FOV: 45 degrees; CFP:
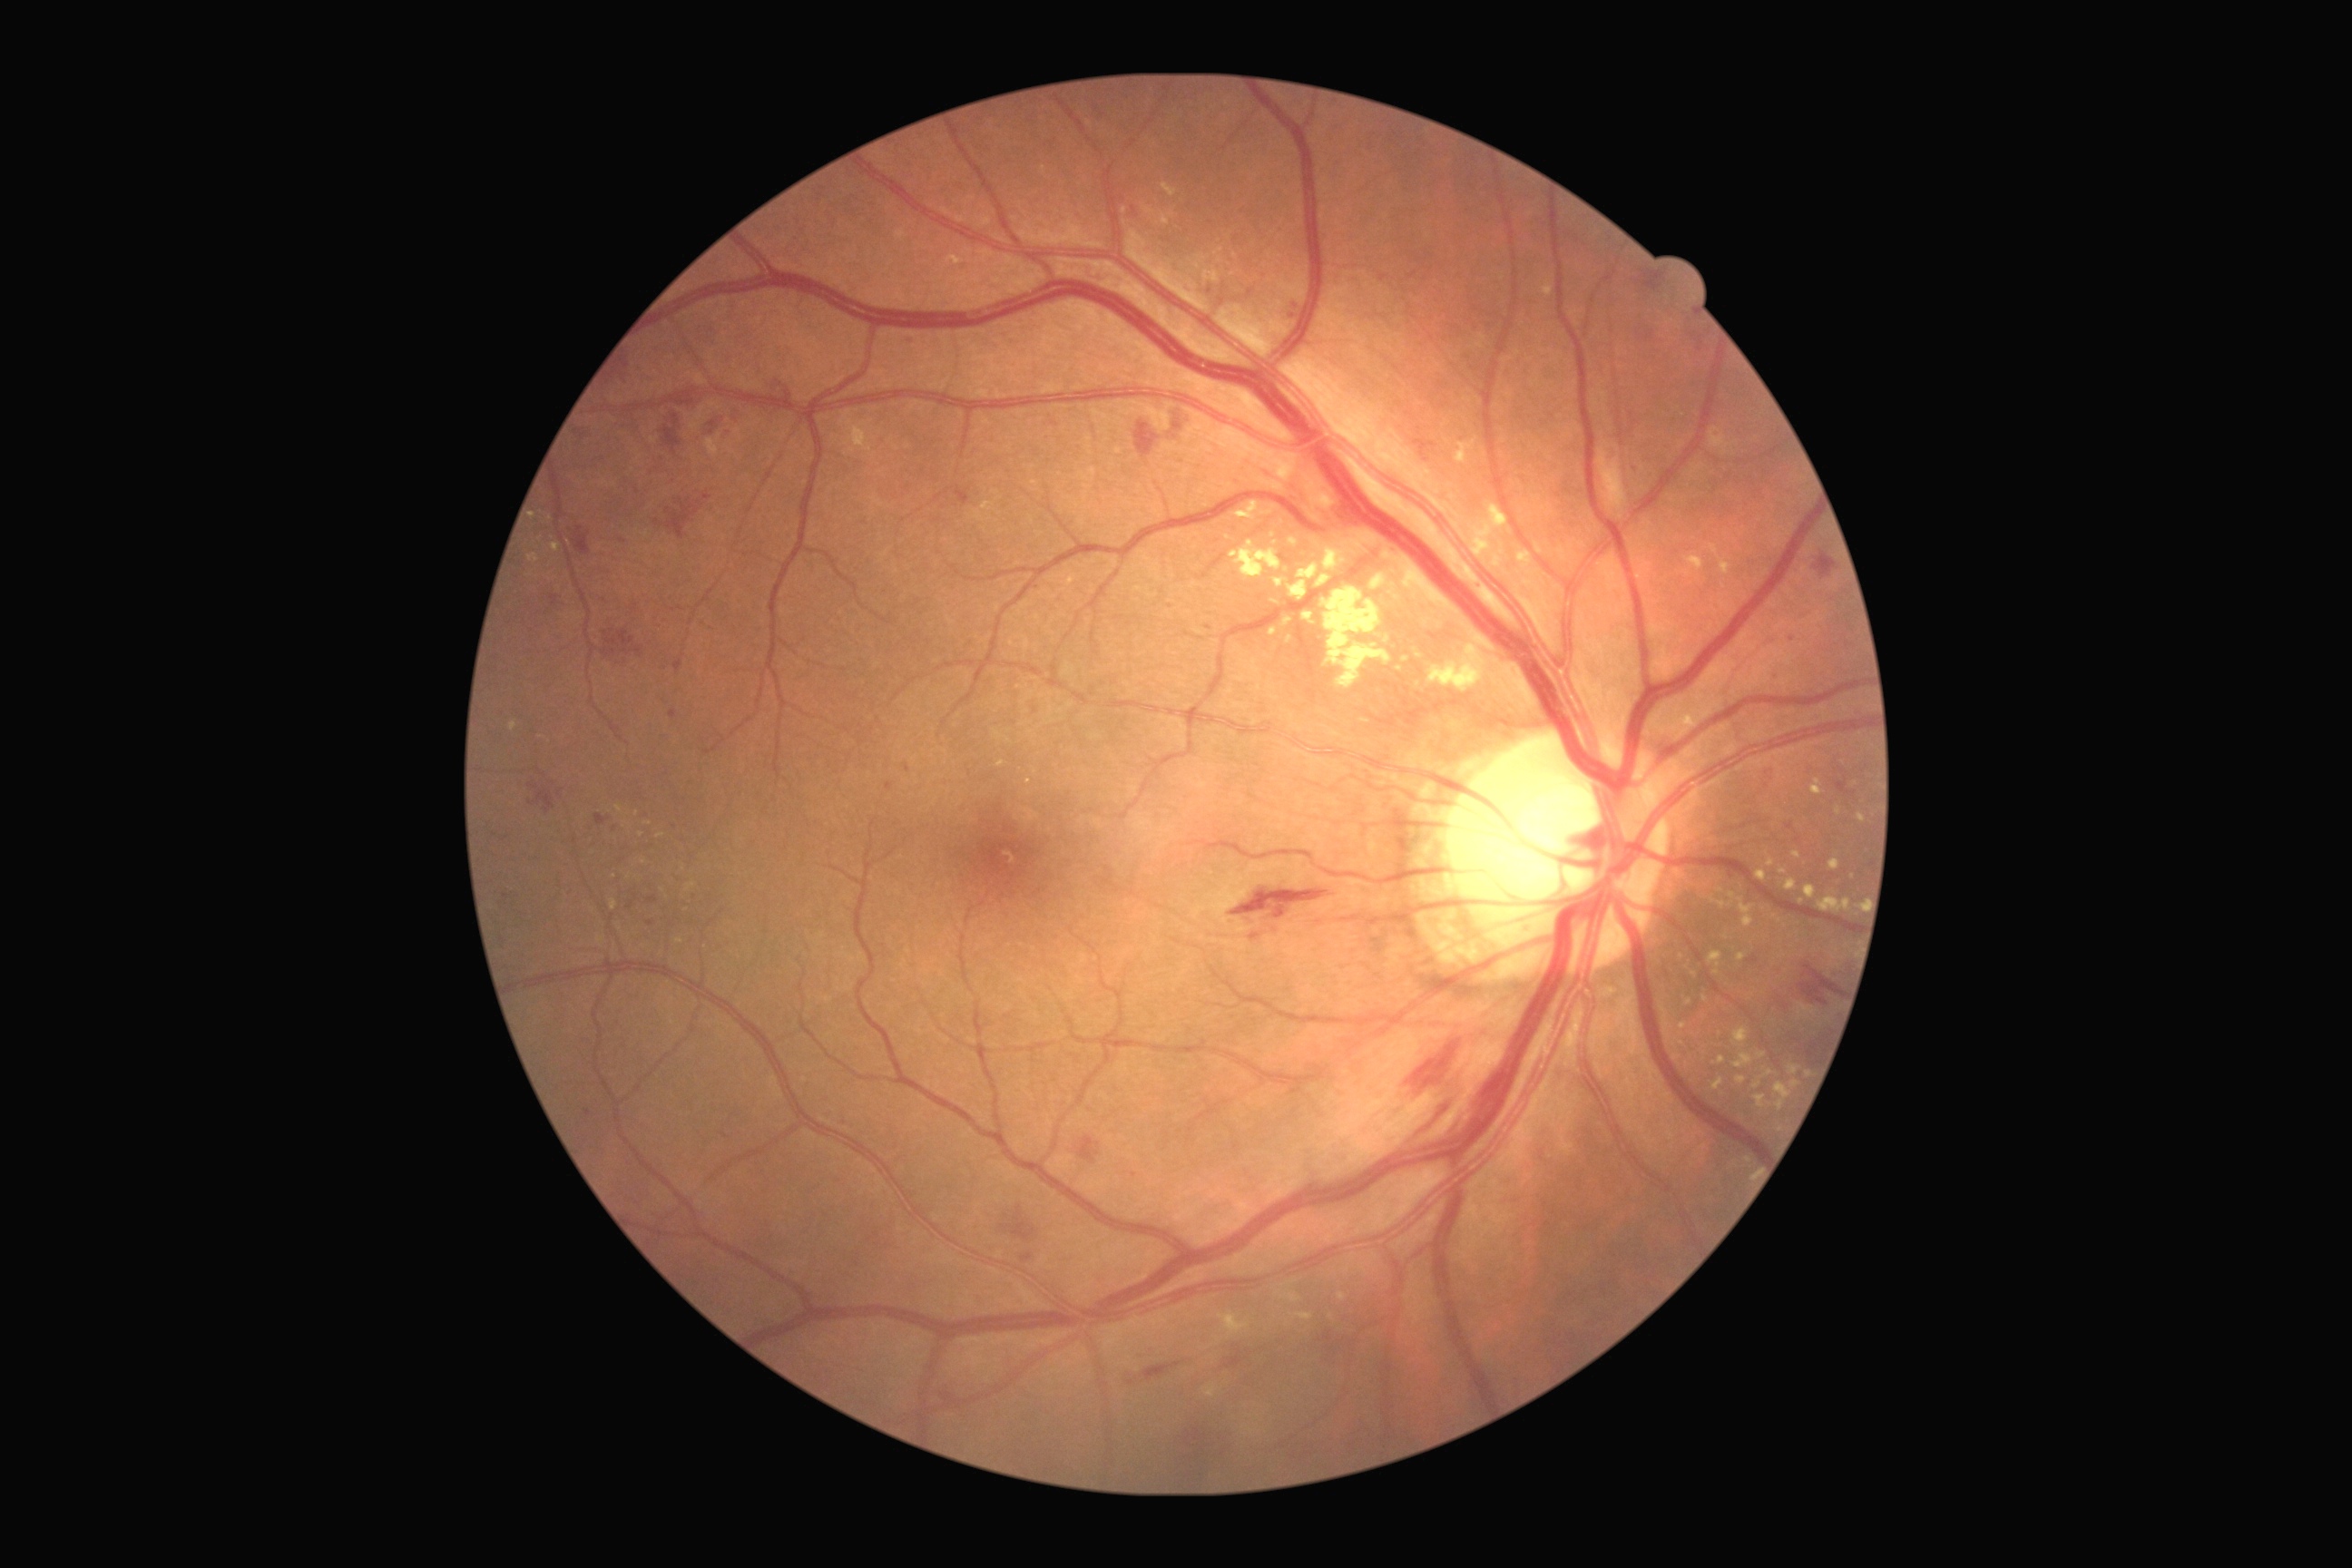 {"partial": true, "dr_grade": 2, "dr_grade_name": "moderate NPDR", "lesions": {"ma": [[701, 493, 709, 496], [905, 337, 914, 344], [669, 709, 678, 720], [500, 838, 509, 843]], "ma_small_approx": [[1295, 306], [588, 1113], [1171, 605], [1293, 316], [675, 827], [1221, 302], [630, 905]], "he": [[1799, 963, 1843, 1006], [1814, 554, 1838, 580], [1135, 422, 1161, 458], [1836, 769, 1857, 798], [603, 629, 643, 658], [1168, 407, 1188, 431], [1230, 888, 1329, 921], [654, 493, 712, 540], [1747, 956, 1759, 965], [549, 594, 558, 607], [1142, 1362, 1182, 1382], [707, 413, 725, 436], [594, 814, 612, 825]], "se": null, "ex": [[1752, 1070, 1774, 1090], [946, 257, 965, 266], [1810, 779, 1823, 796], [1685, 554, 1703, 573], [1779, 868, 1787, 874], [1828, 859, 1841, 872], [1322, 587, 1391, 687], [1745, 914, 1754, 928], [511, 723, 518, 732], [1729, 745, 1738, 756], [529, 554, 540, 562], [1536, 544, 1544, 556], [1456, 438, 1478, 466], [1758, 1052, 1767, 1059]], "ex_small_approx": [[1044, 170], [661, 836], [614, 875], [619, 809], [1748, 1160]]}}